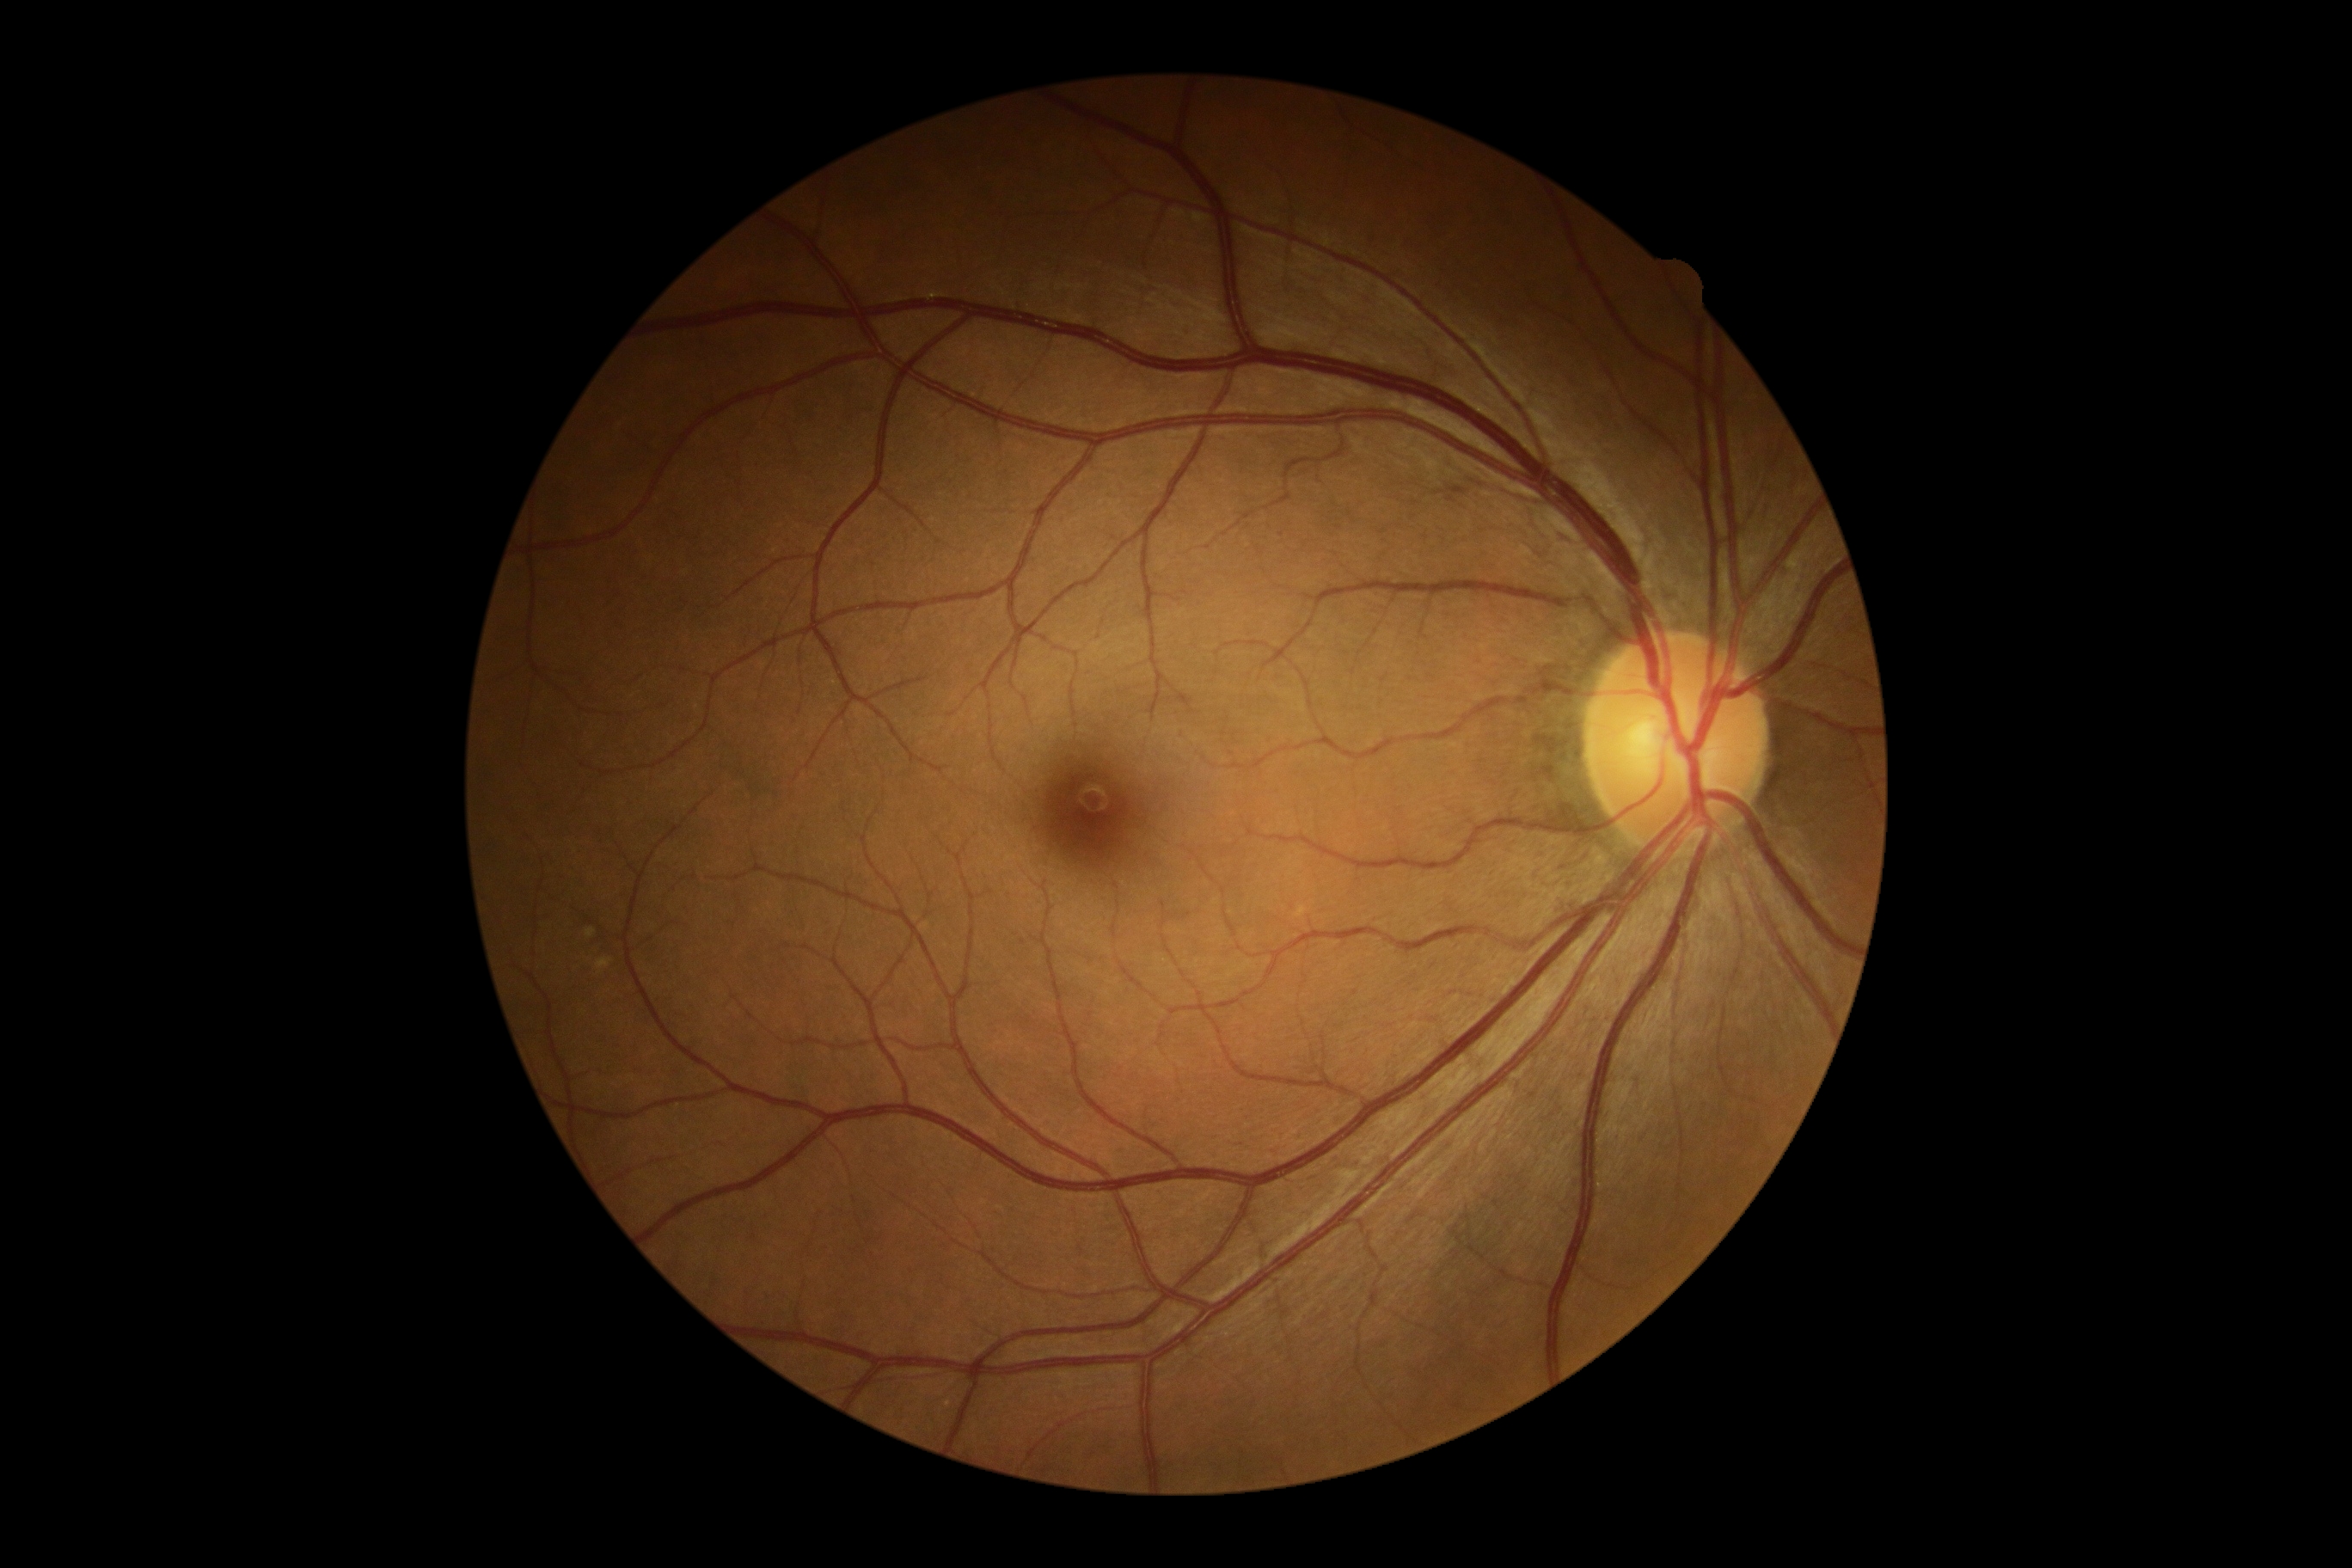 - DR impression — negative for DR
- retinopathy grade — 0